Color fundus photograph
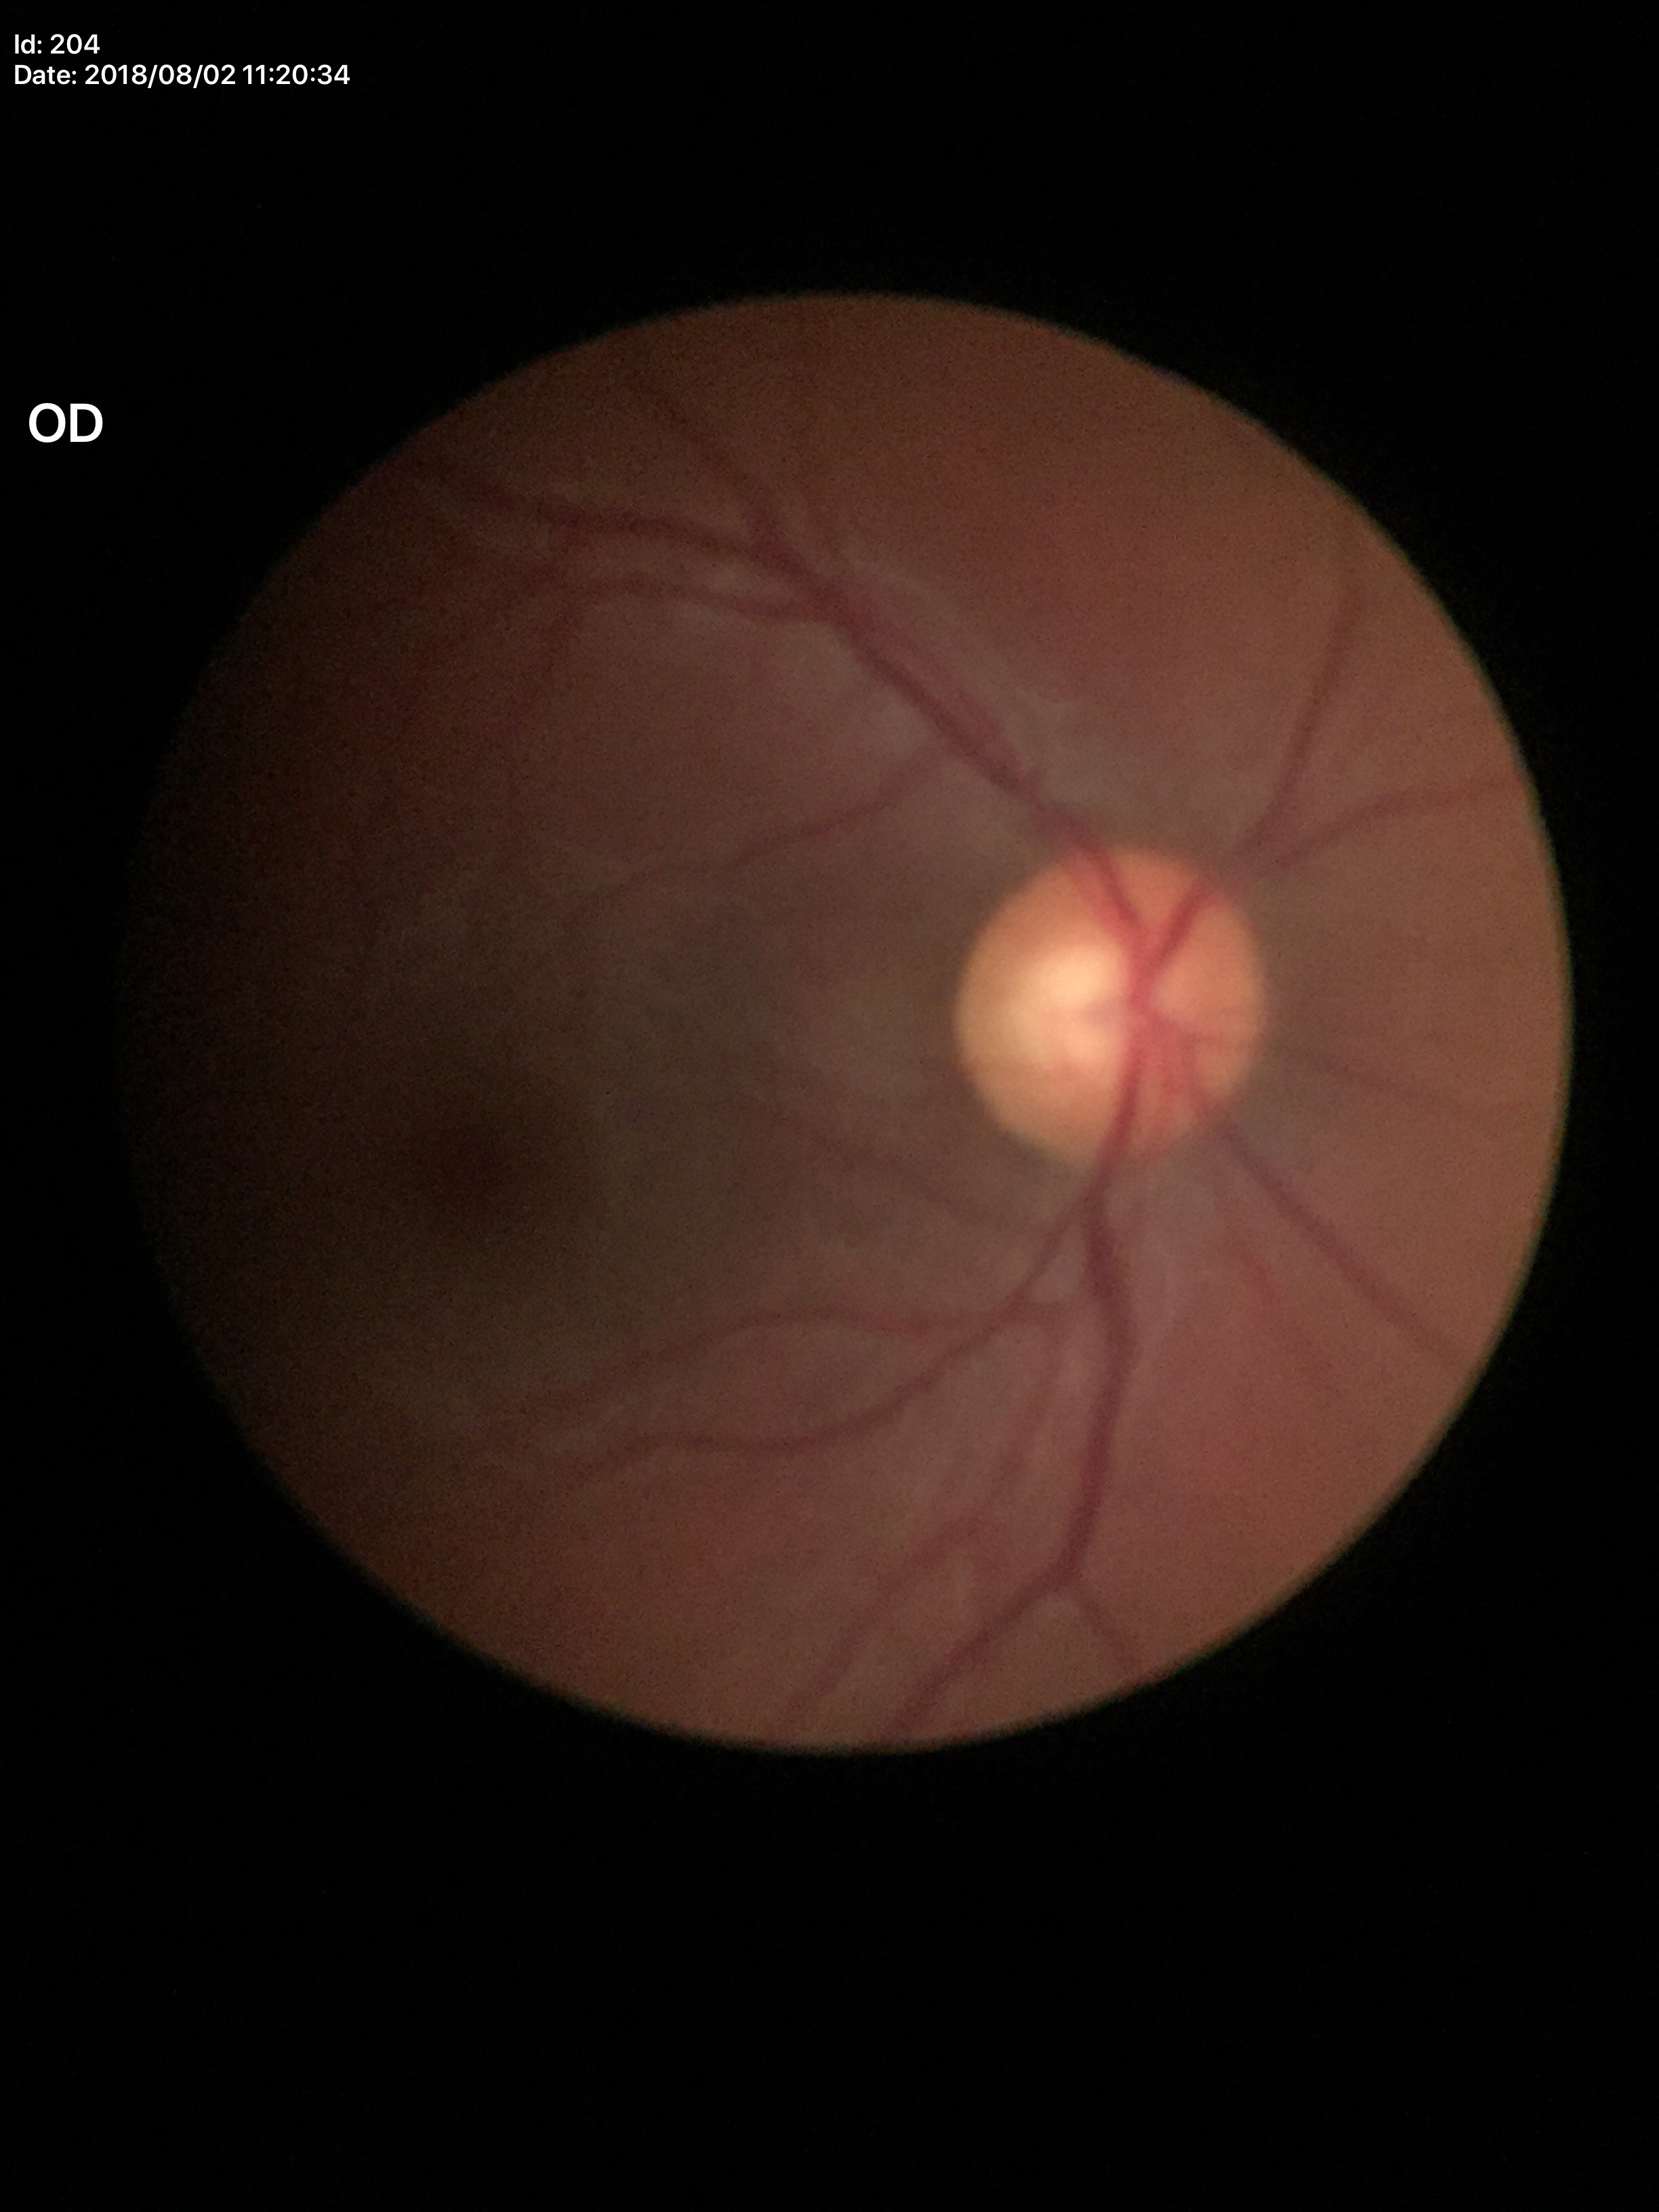 vertical cup-disc ratio: 0.55
Glaucoma screening: no suspicious findings (unanimous normal call)